RetCam wide-field infant fundus image. Image size 640x480. 130° field of view (Clarity RetCam 3).
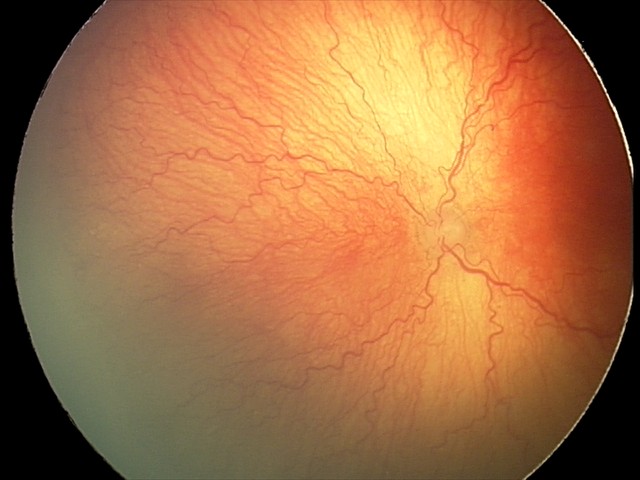
Screening examination consistent with aggressive retinopathy of prematurity — rapidly progressive severe ROP with prominent plus disease, often without classic stage progression.
Plus disease was diagnosed.